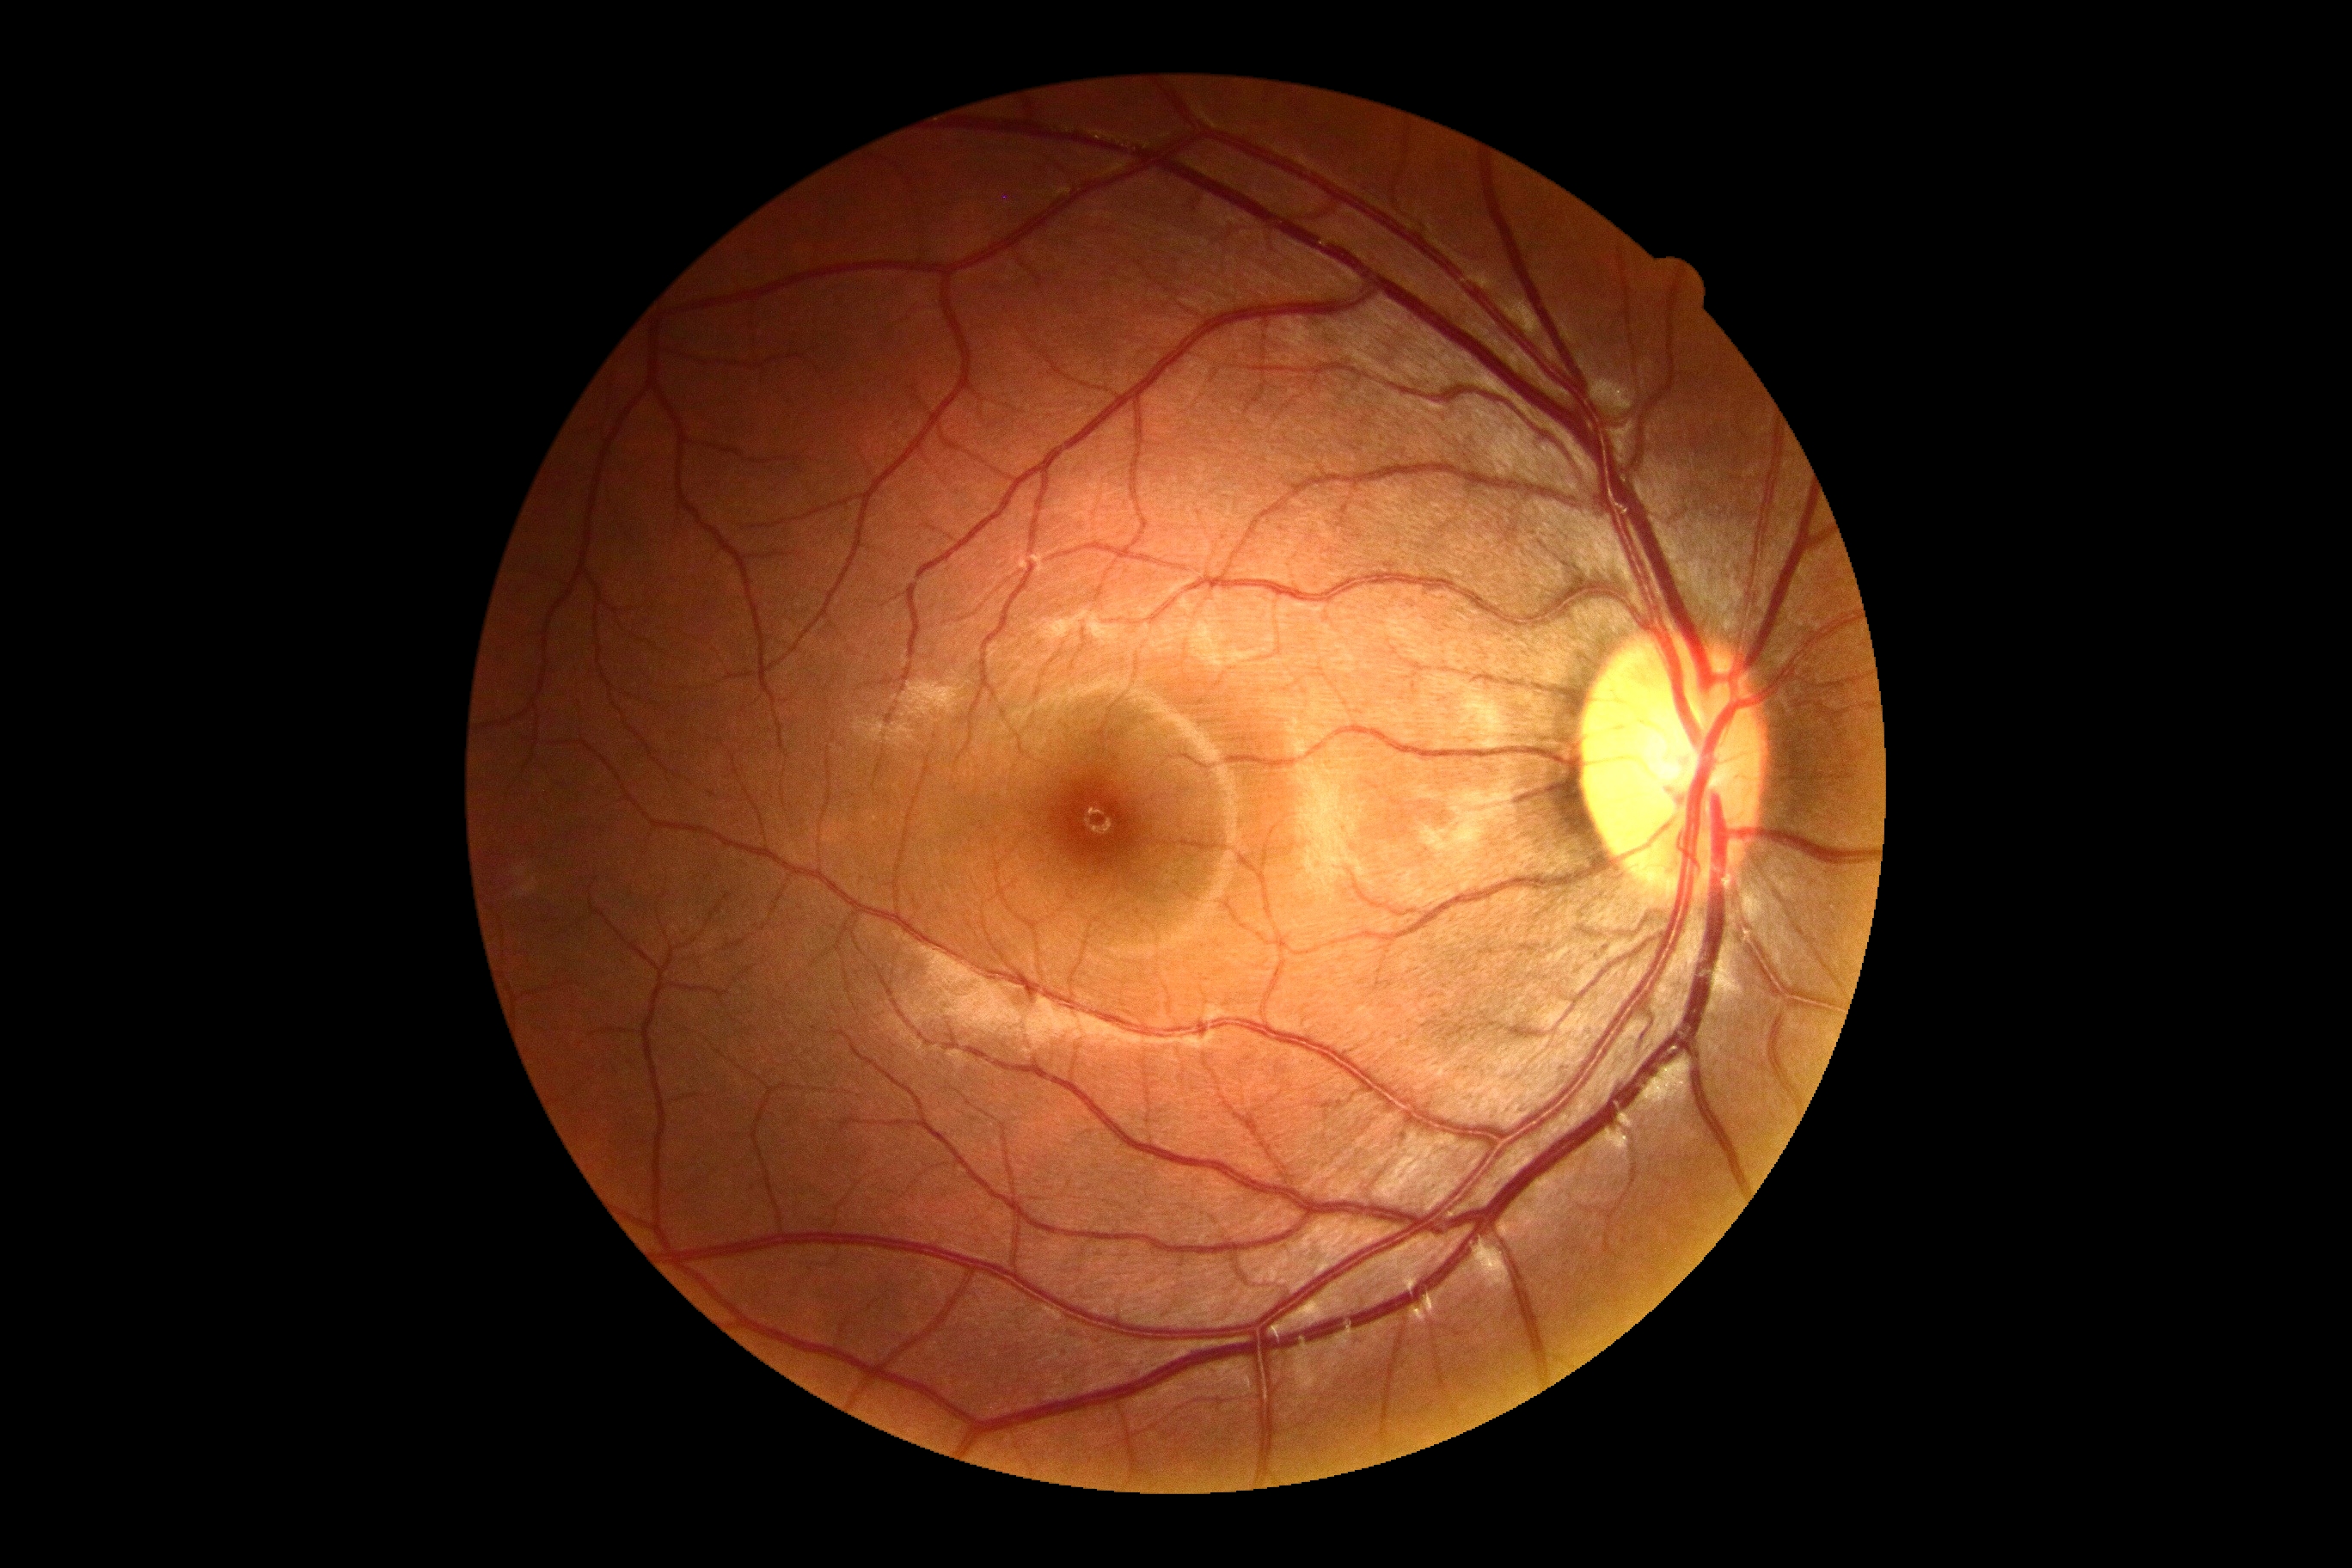

Annotations:
– DR severity — no apparent retinopathy (grade 0)
– DR impression — no signs of DR